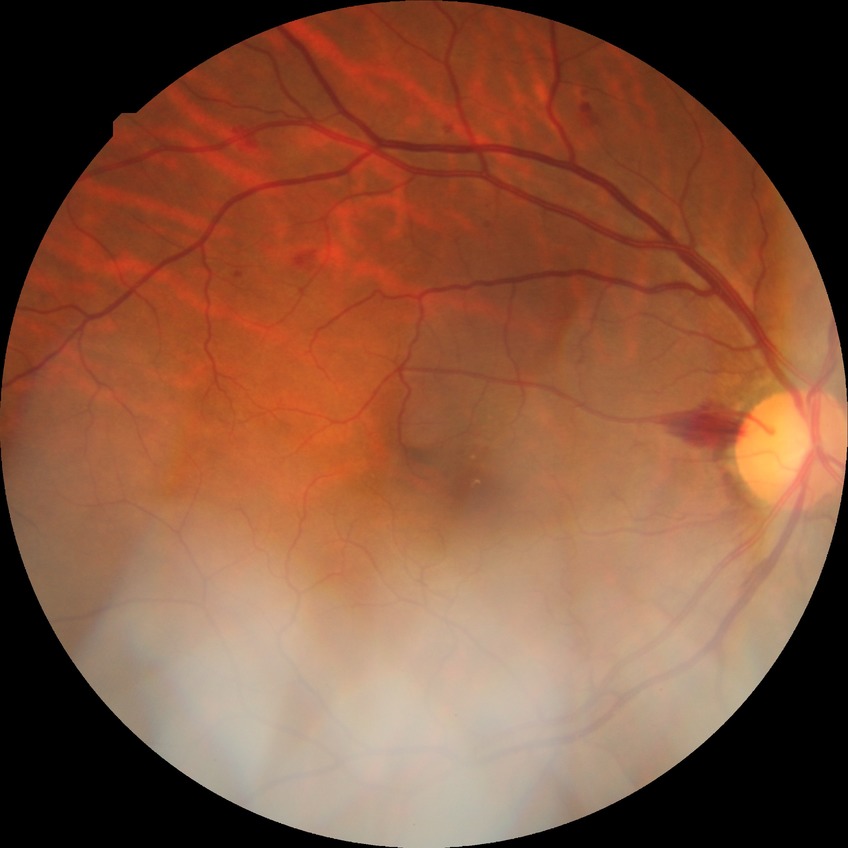
Diabetic retinopathy (DR): simple diabetic retinopathy (SDR).